61-year-old patient: 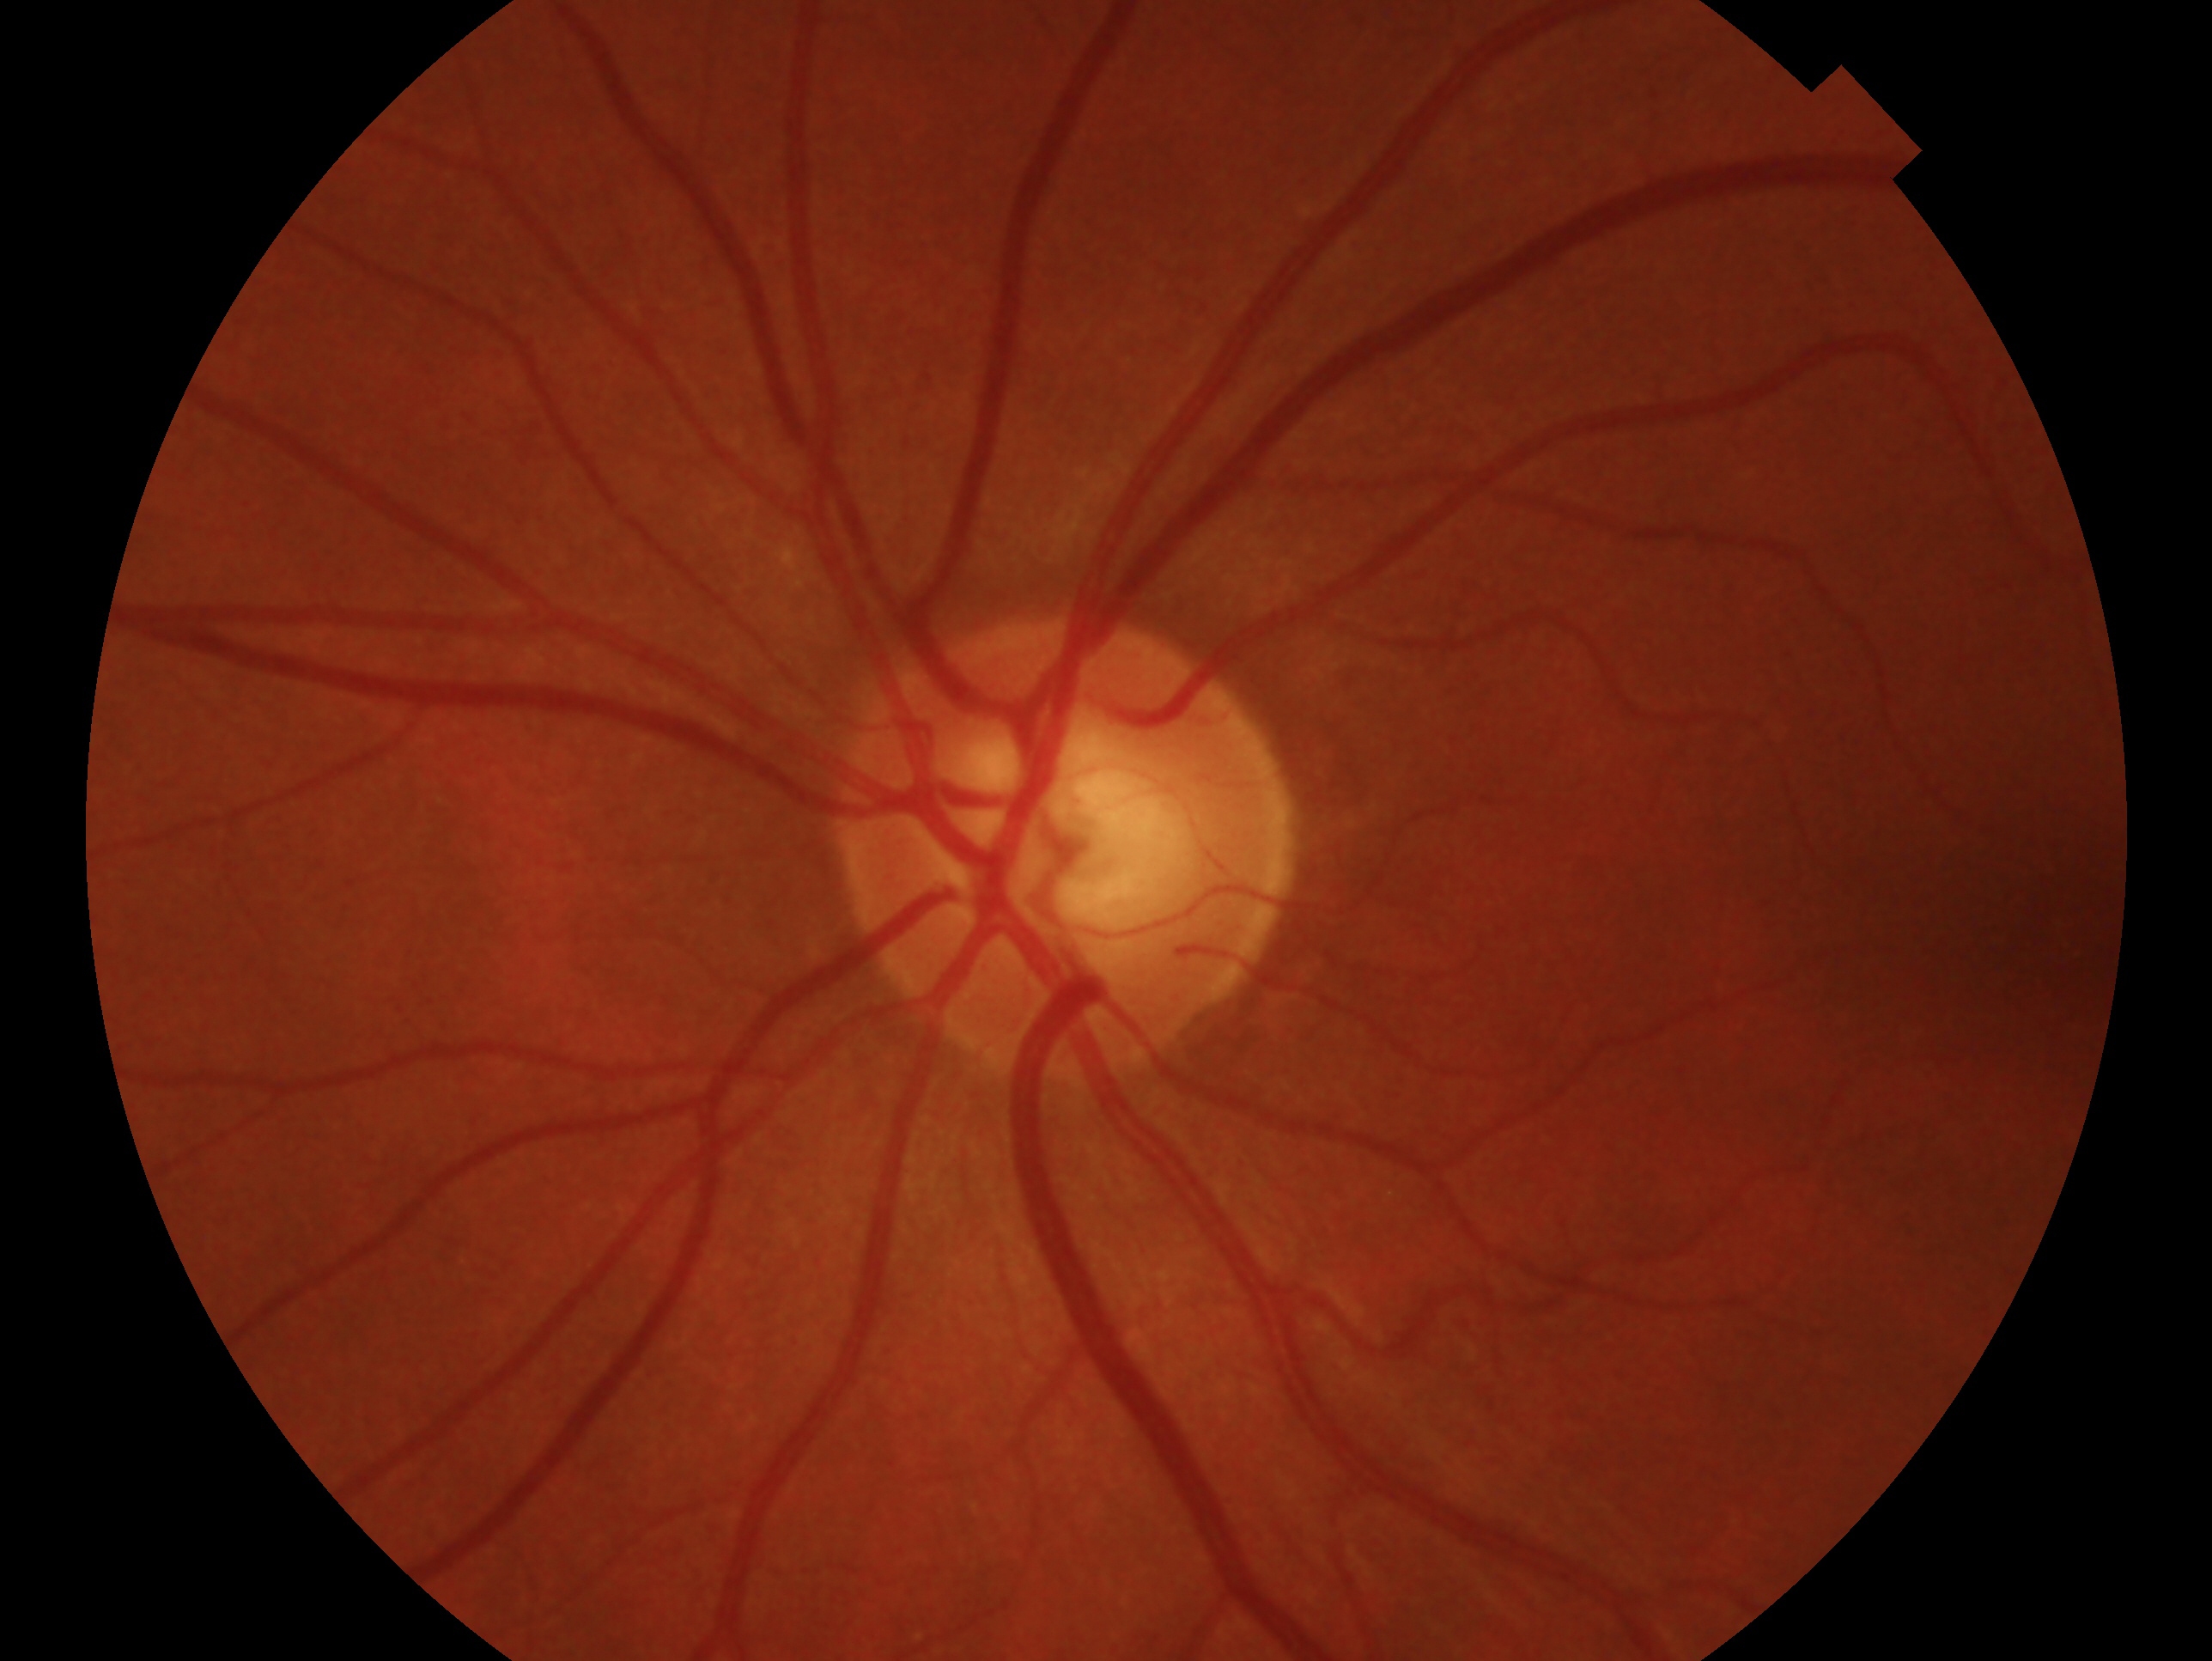

assessment: no glaucomatous findings; laterality: left eye.